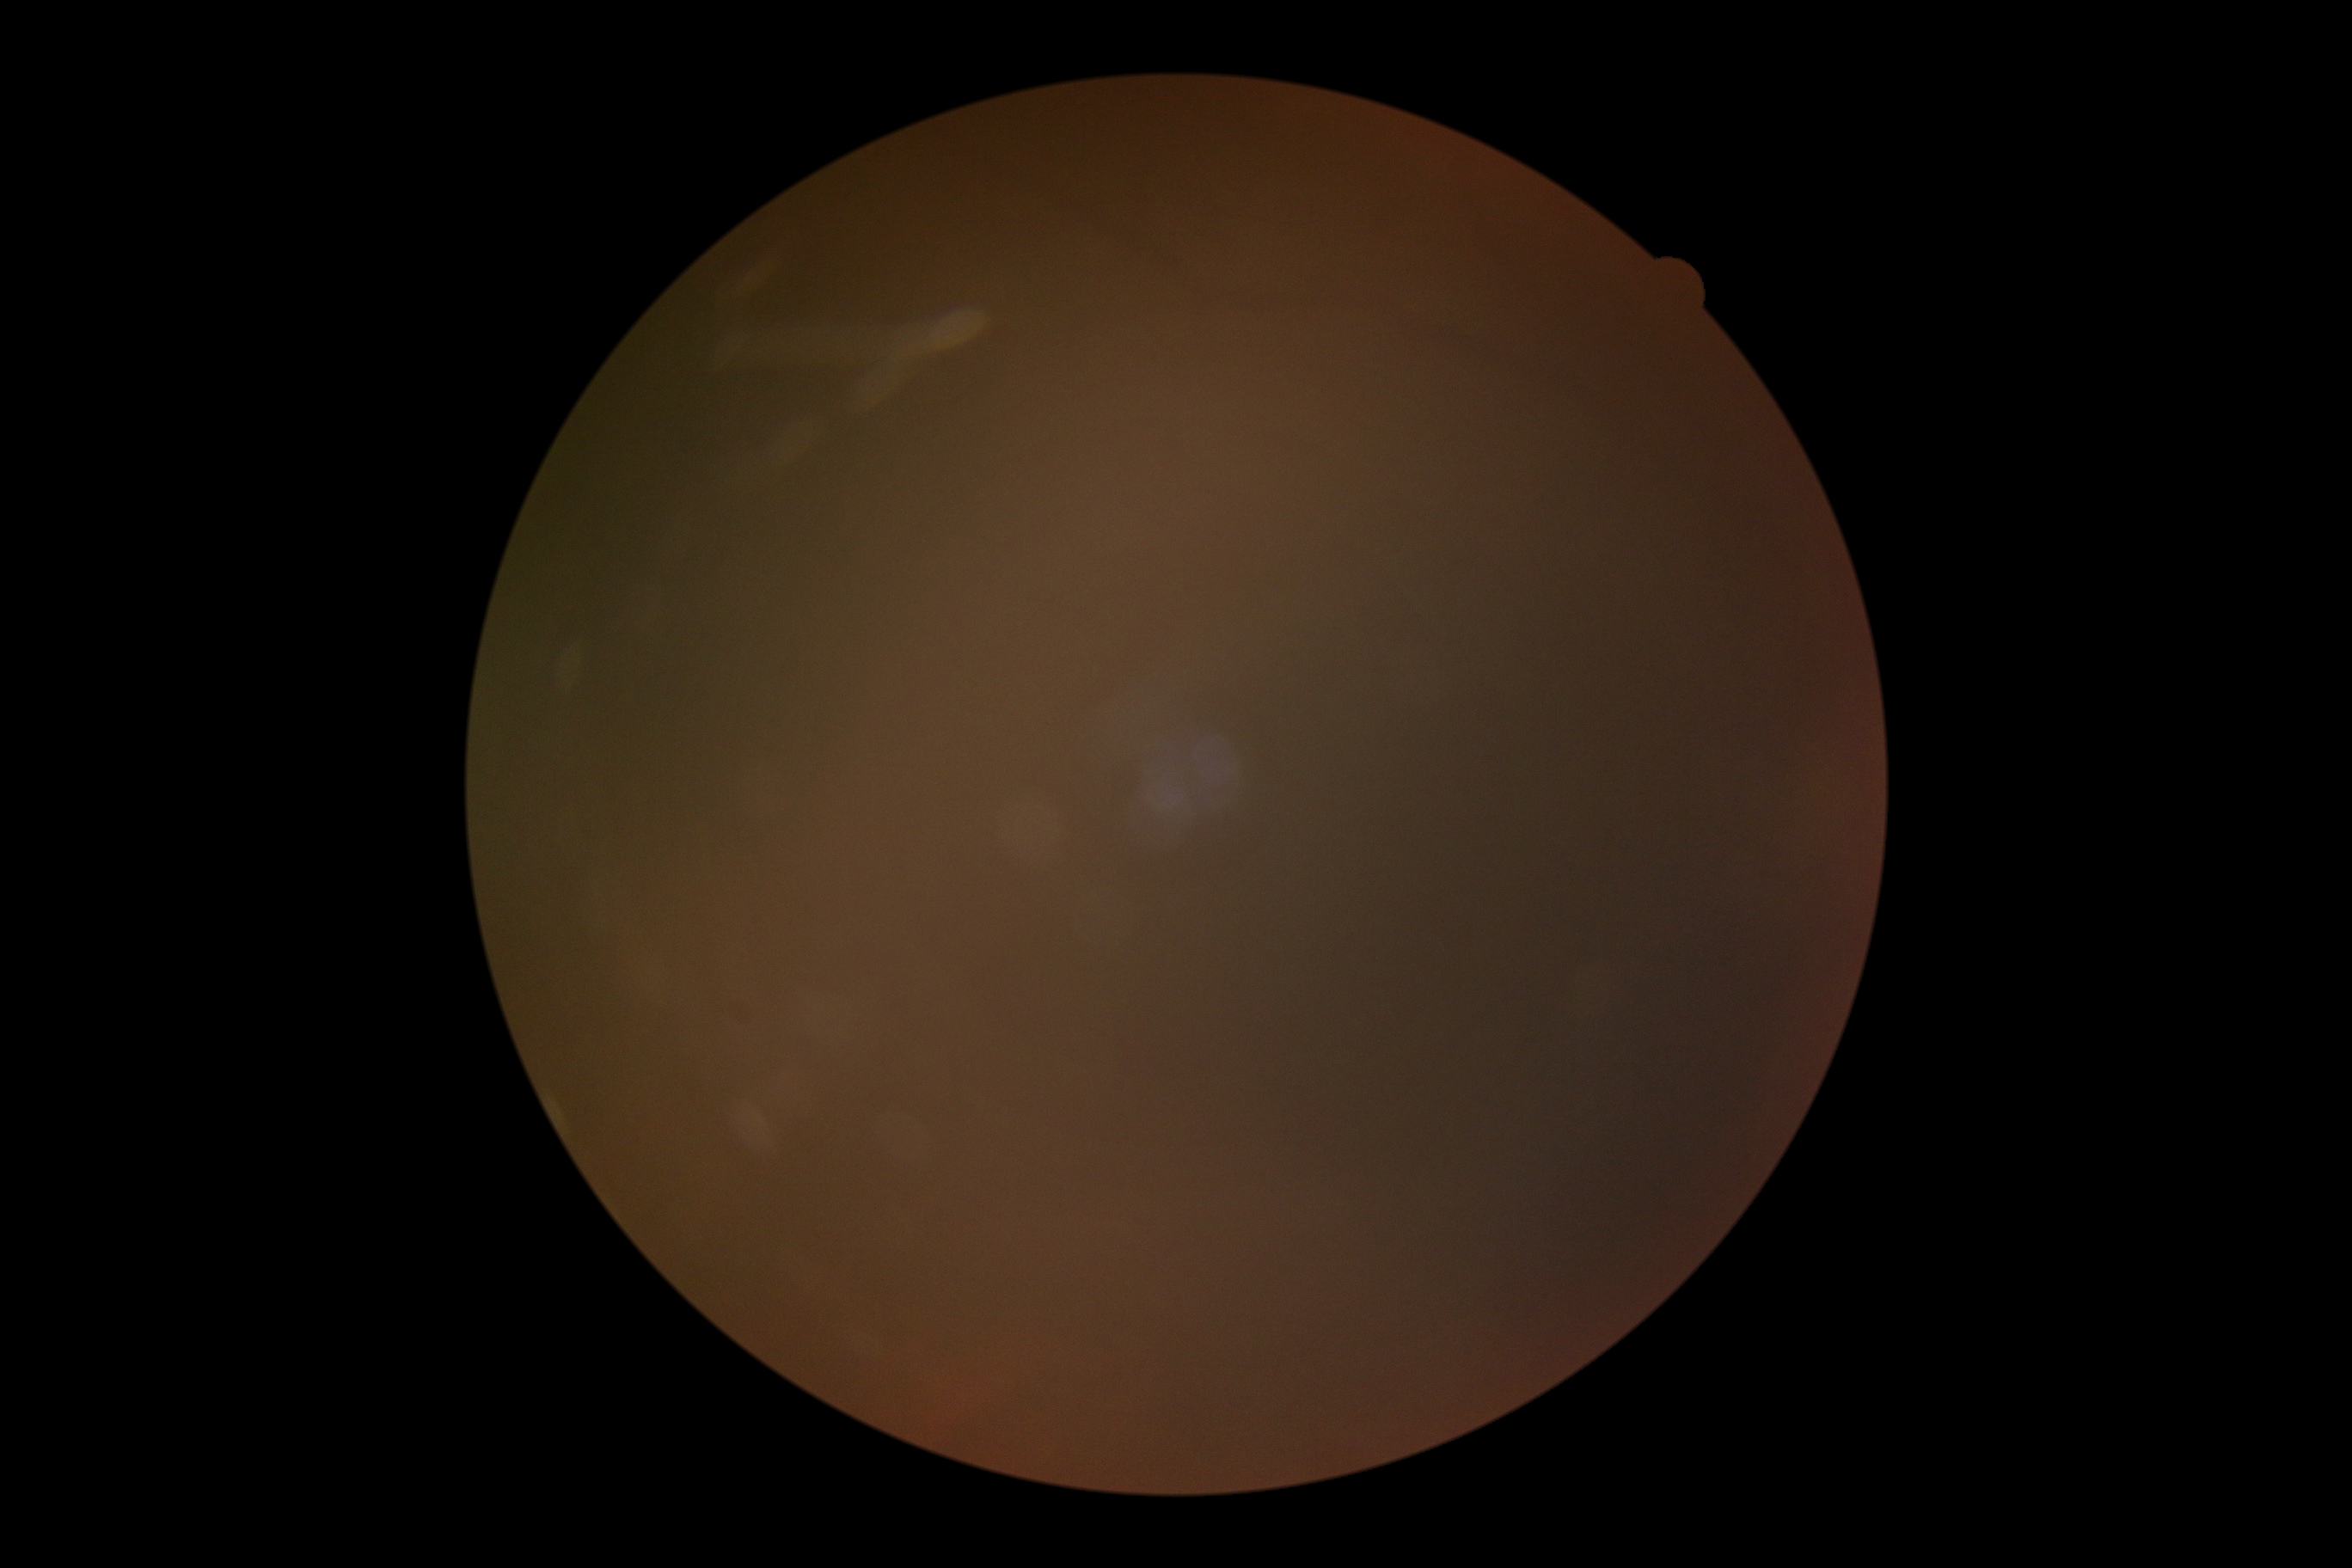 Ungradable image — DR severity cannot be determined. Diabetic retinopathy (DR): ungradable.